Color fundus photograph — 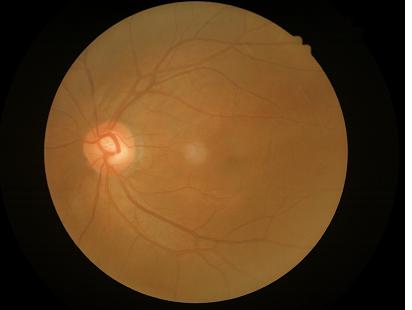

Image quality assessment: contrast: low, vessels and details hard to distinguish | sharpness: sharp throughout the field | overall: good, gradable.